Nonmydriatic; 45° field of view.
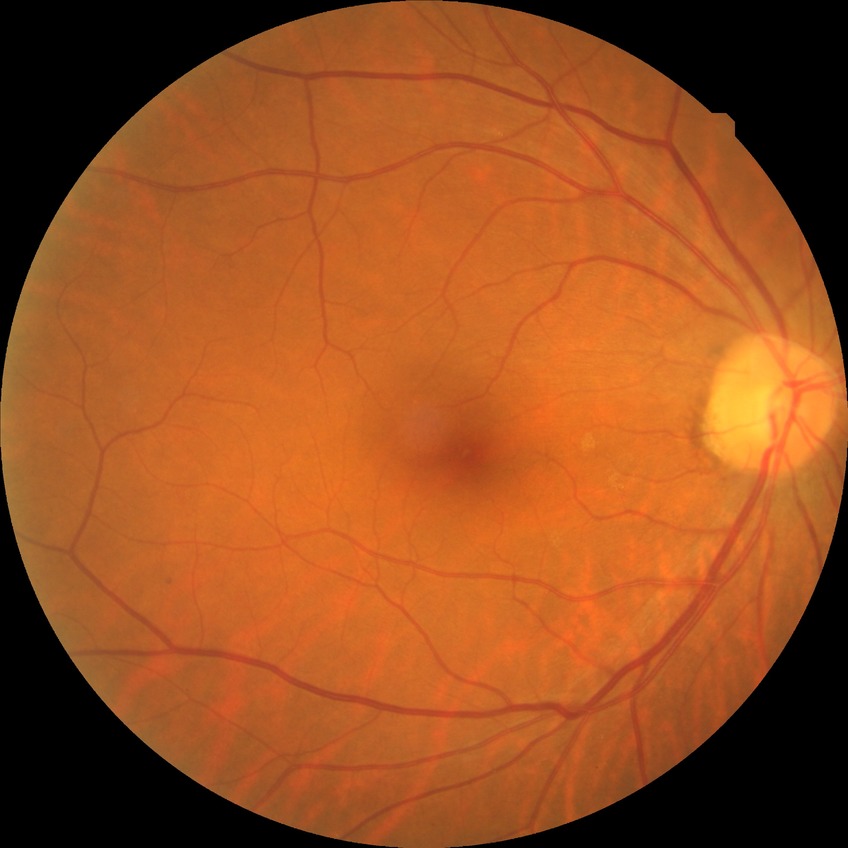
Modified Davis classification: no diabetic retinopathy.